NIDEK AFC-230; 848x848; color fundus photograph; 45 degree fundus photograph — 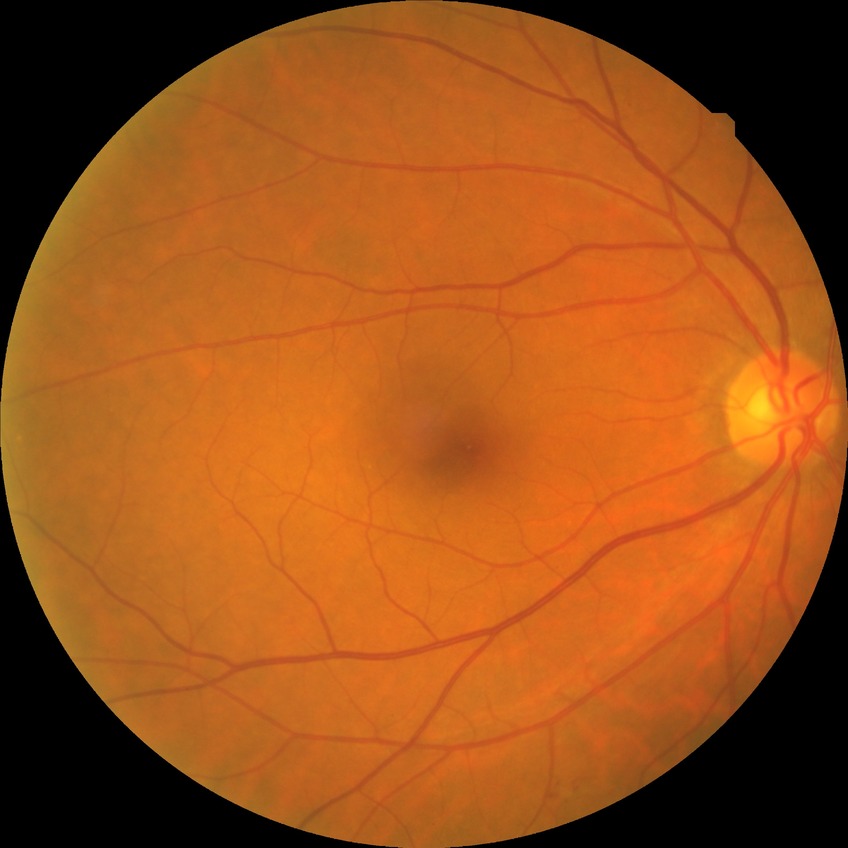
Diabetic retinopathy (DR) is NDR (no diabetic retinopathy).